Retinal fundus photograph — 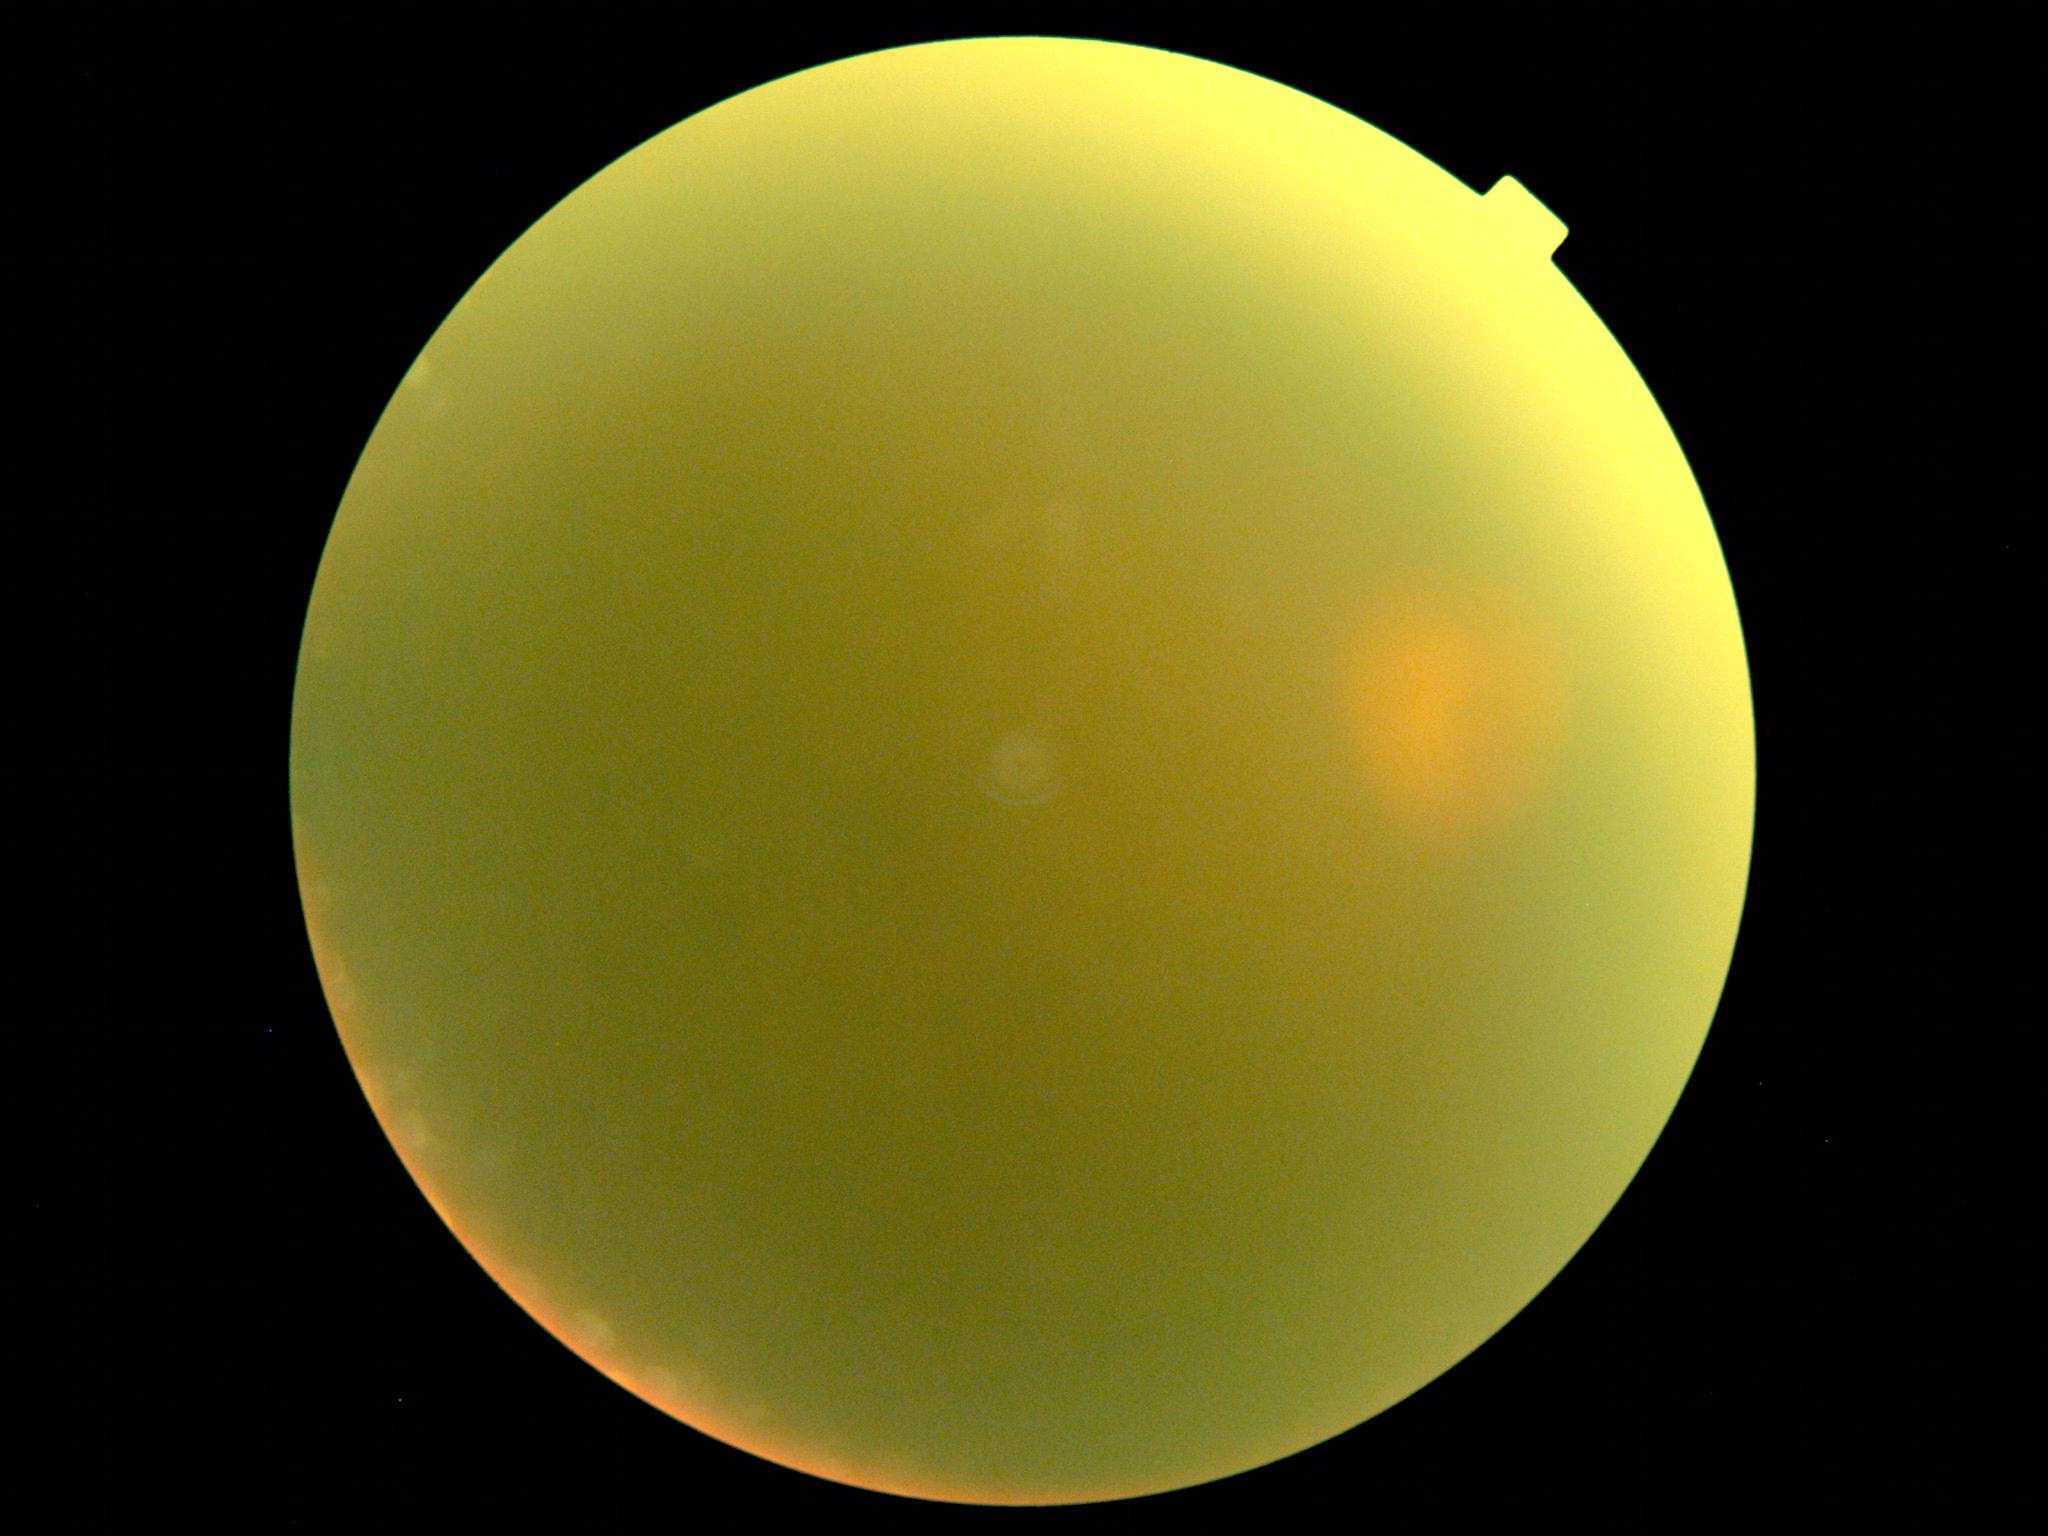
quality: insufficient
dr_grade: ungradable